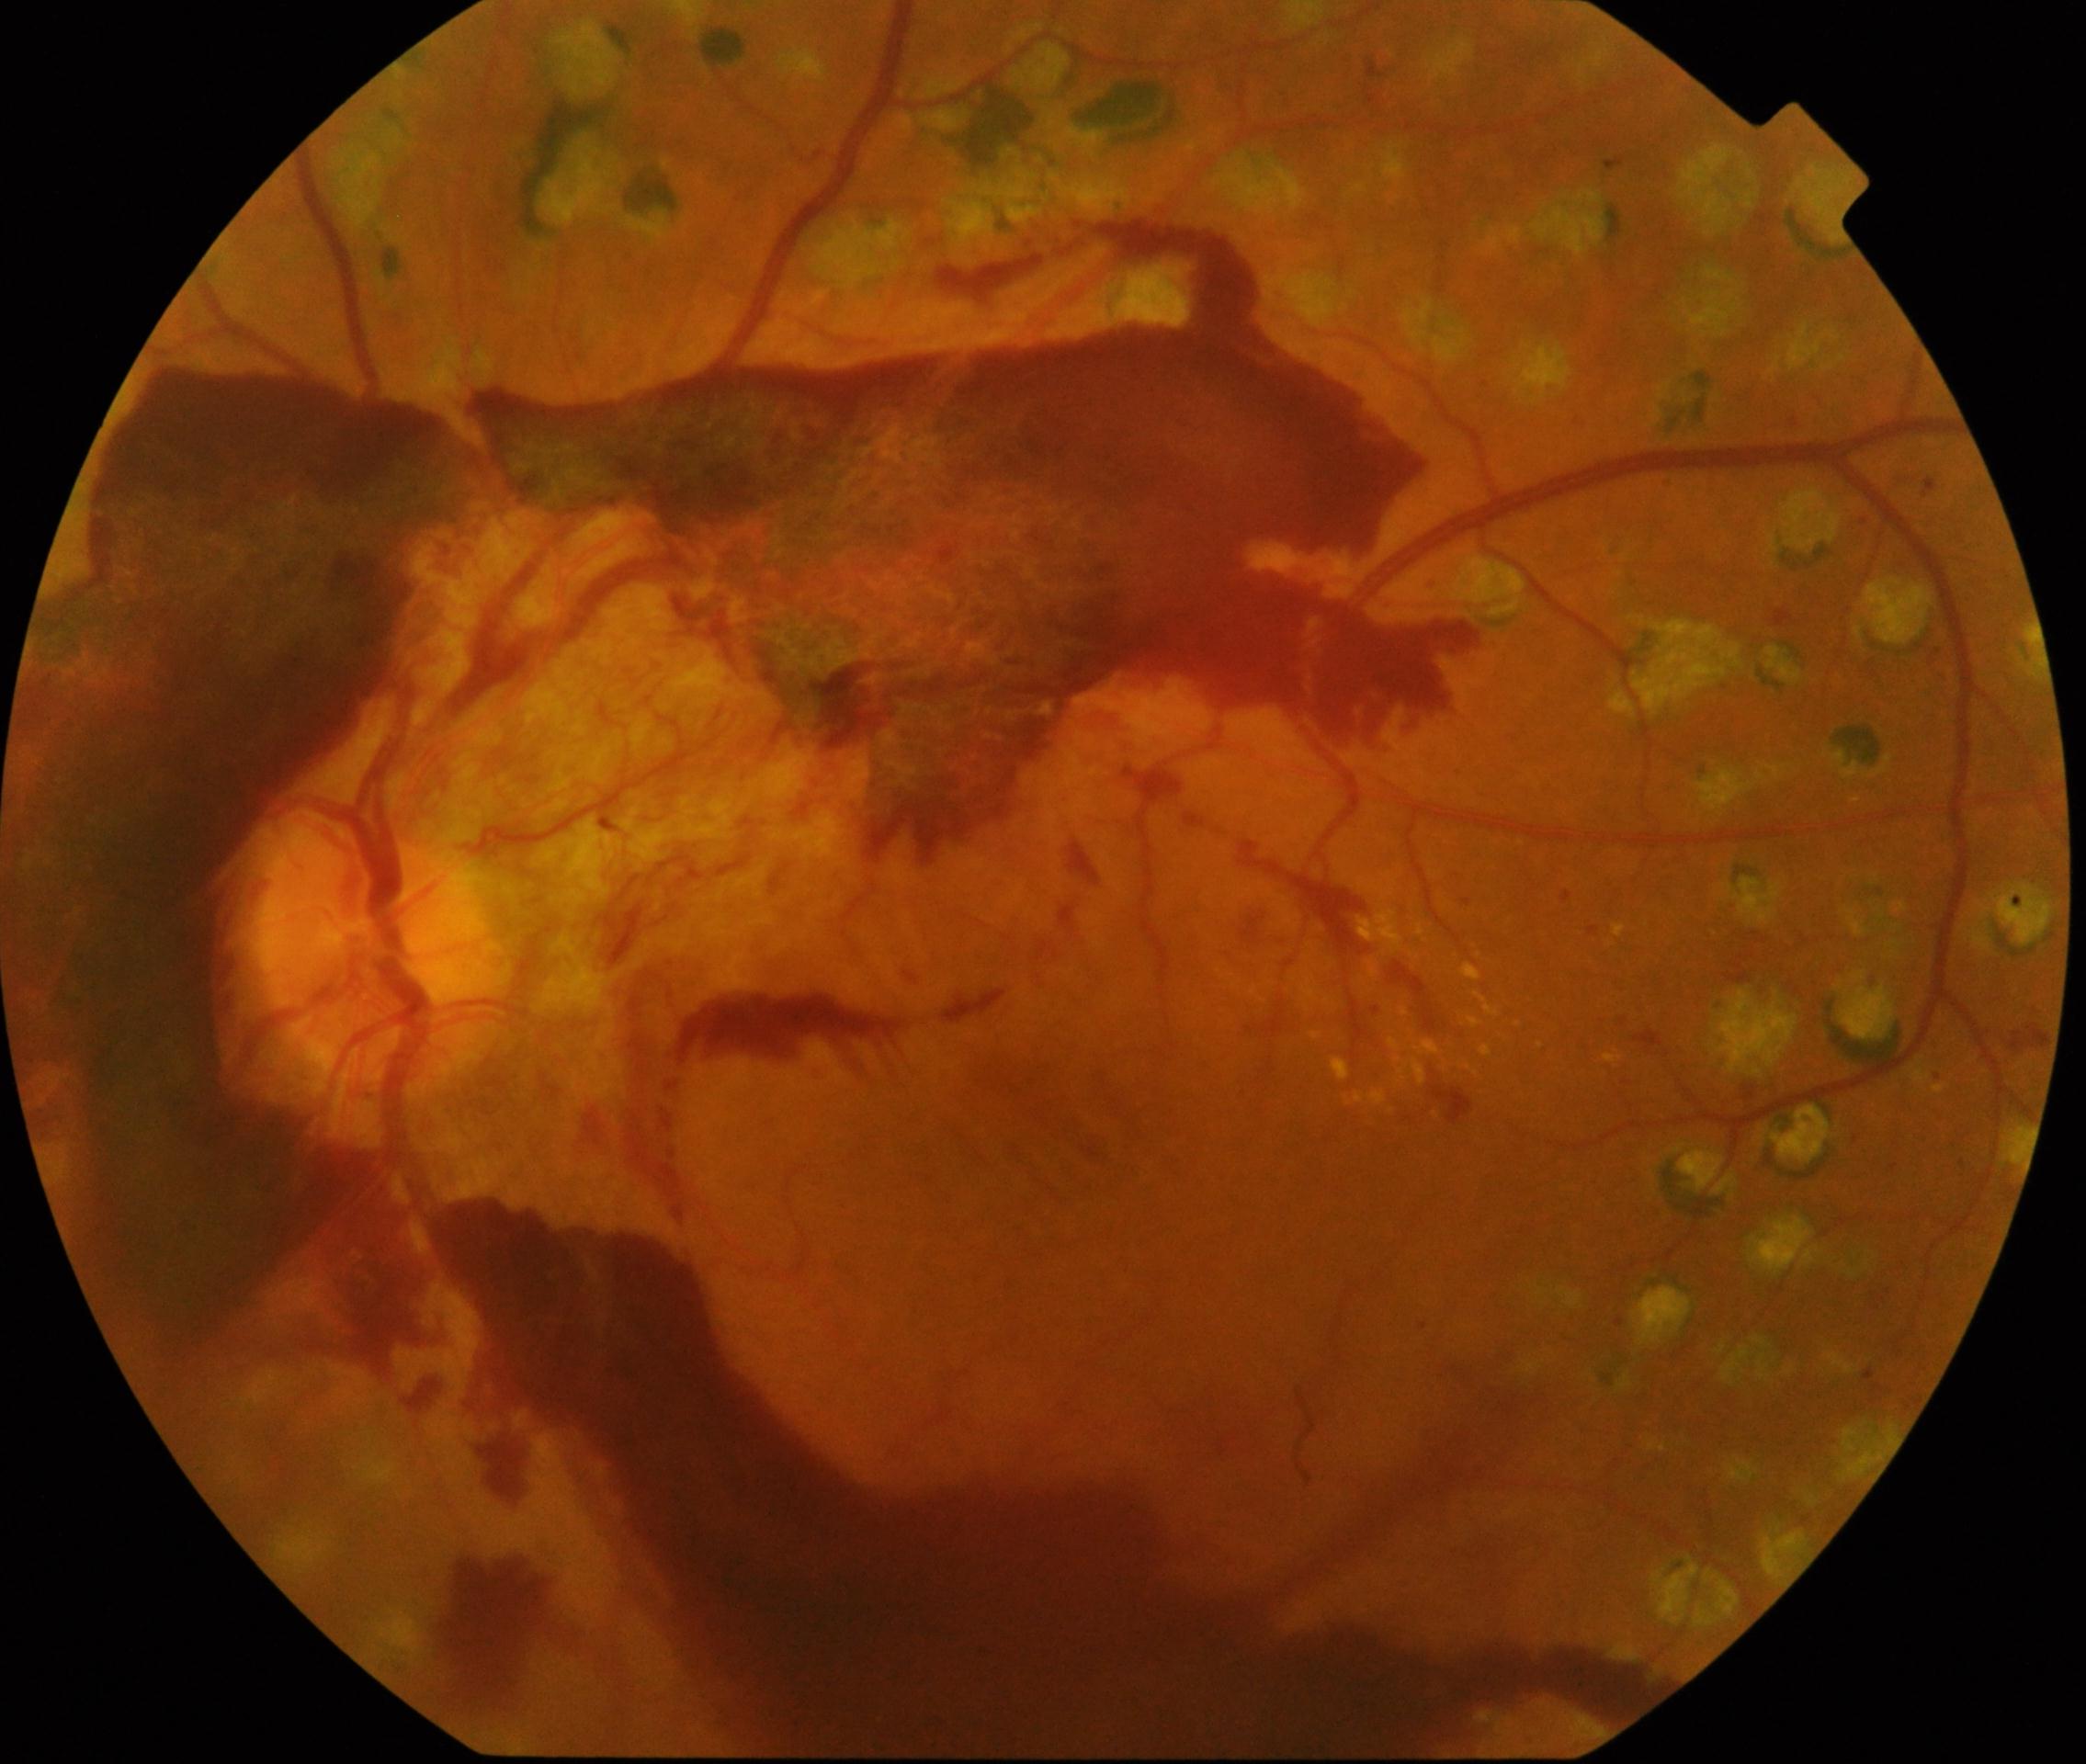
diabetic retinopathy grade = proliferative diabetic retinopathy (4).